Female patient · centered on the optic disc · color fundus photograph · intraocular pressure 17 mmHg: 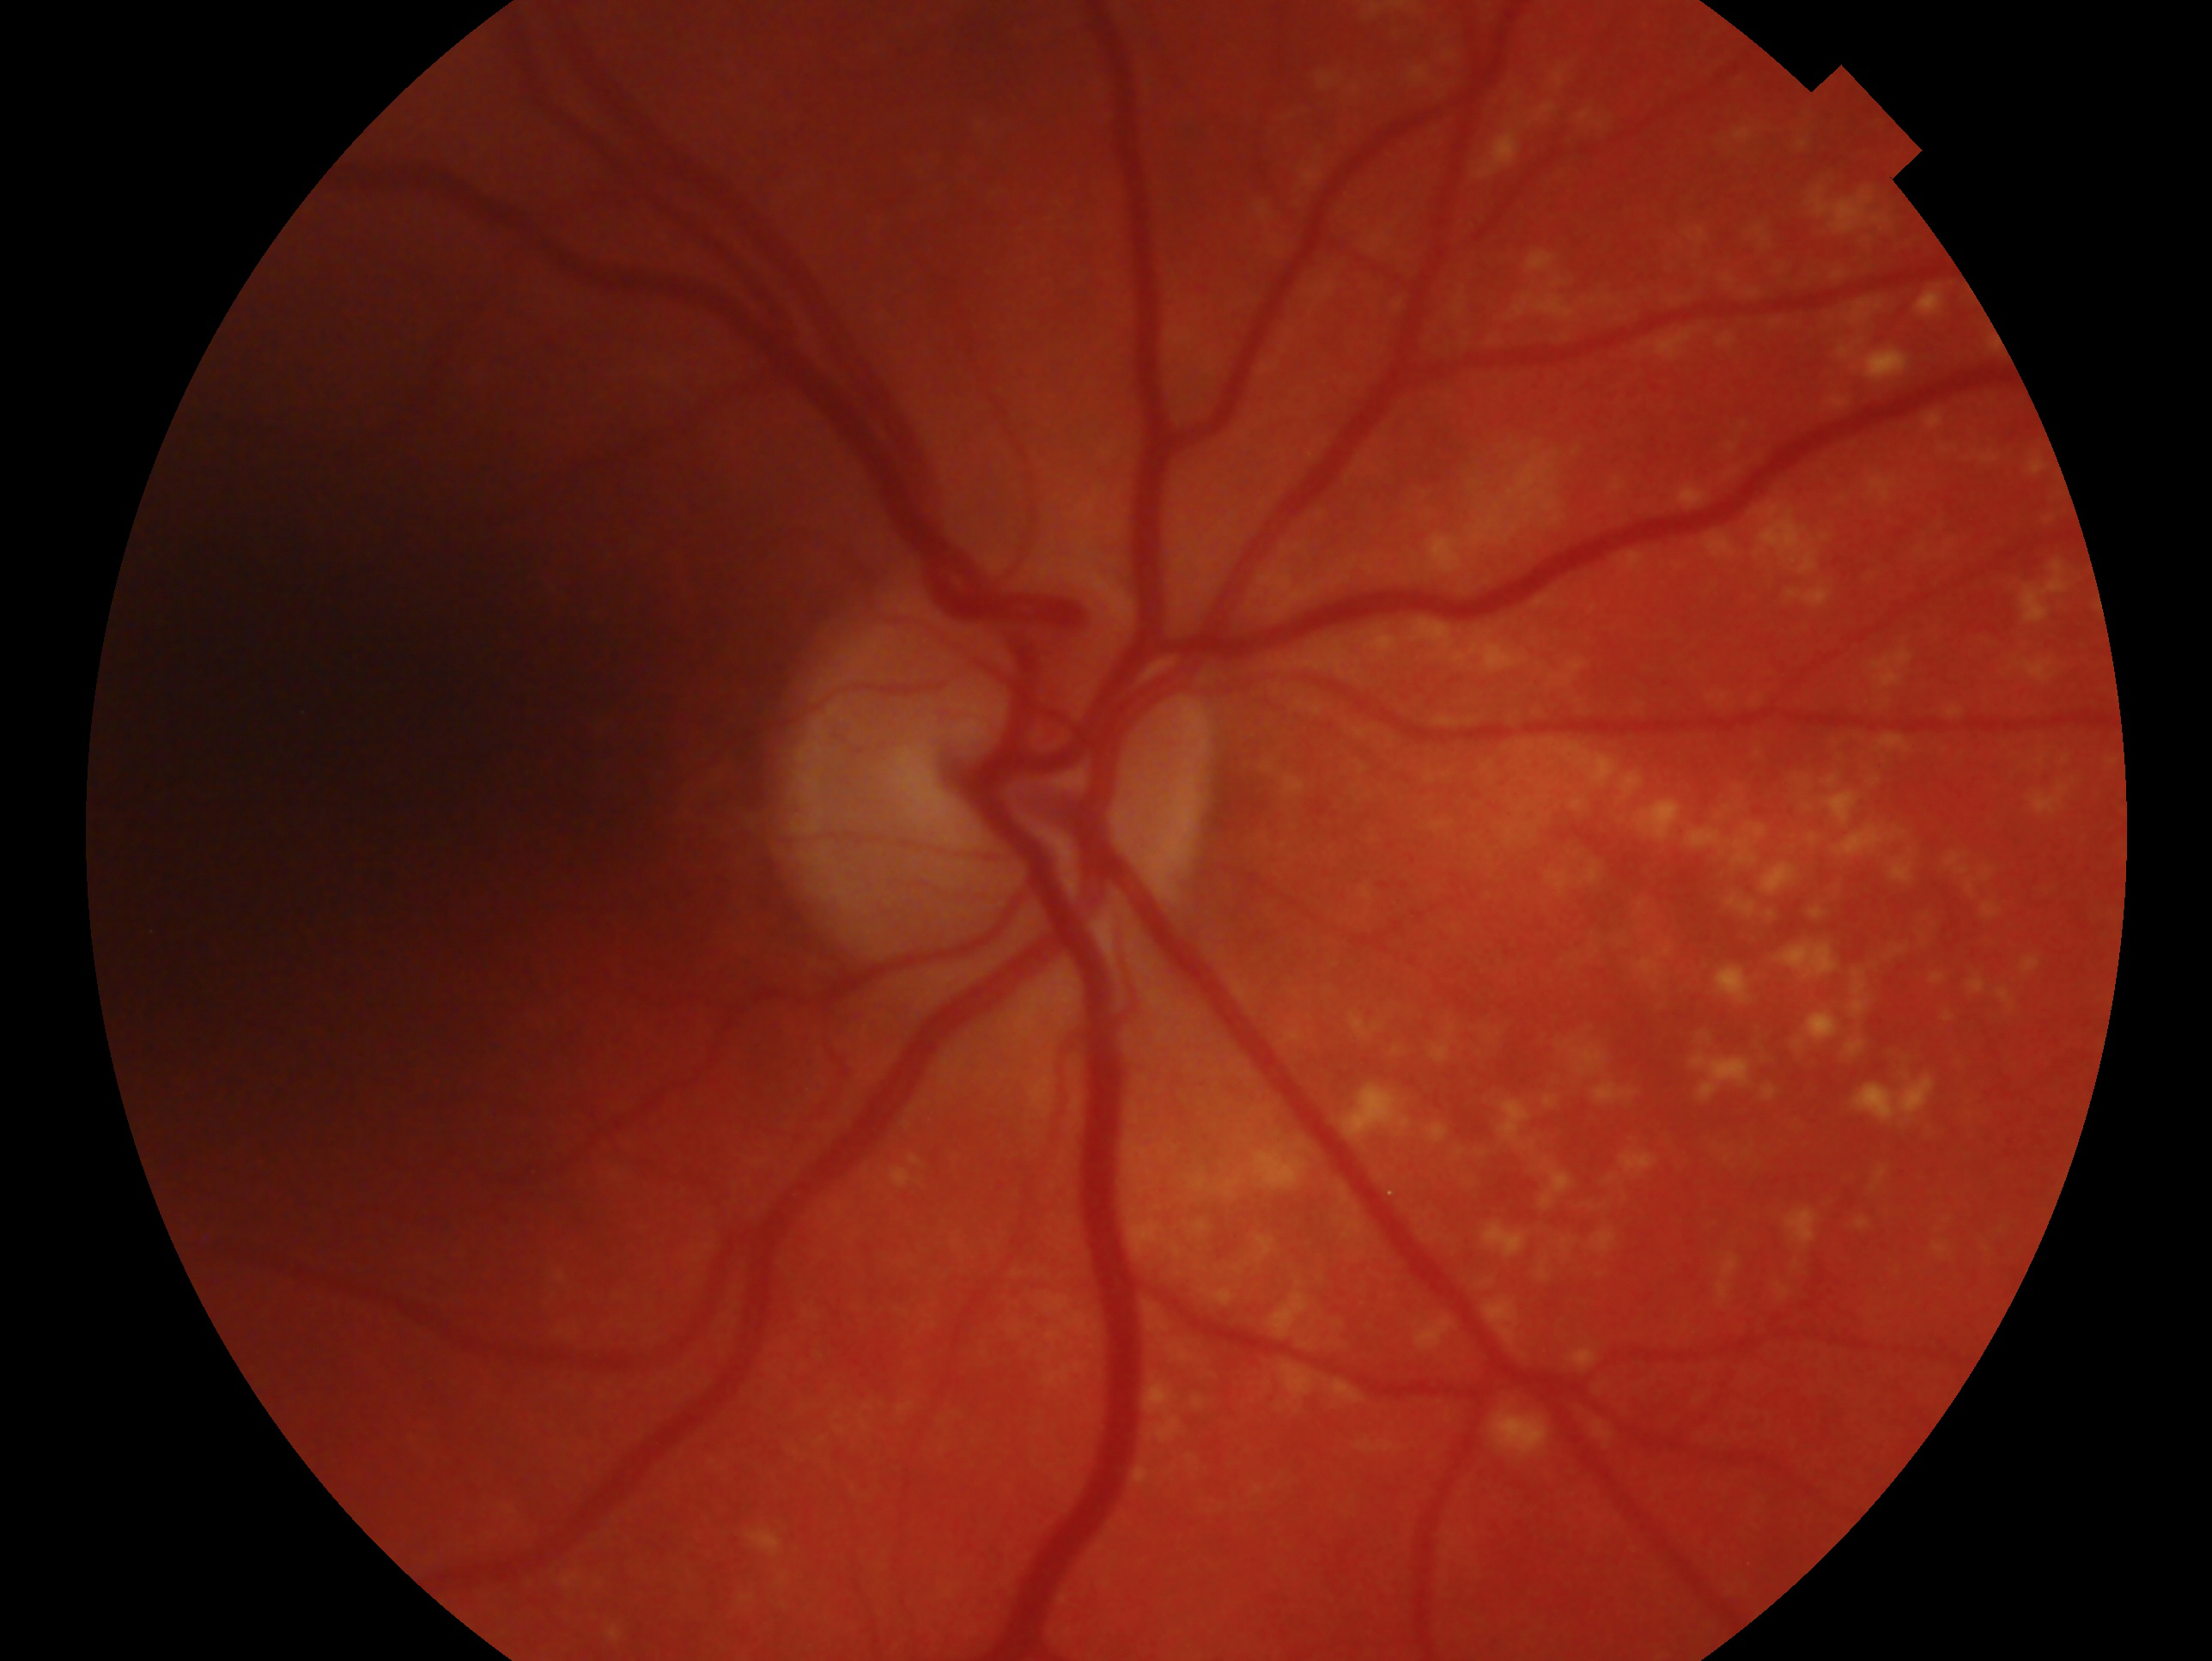
glaucoma diagnosis=glaucomatous — clinically confirmed glaucoma with characteristic optic nerve damage | laterality=oculus dexter.